Modified Davis grading
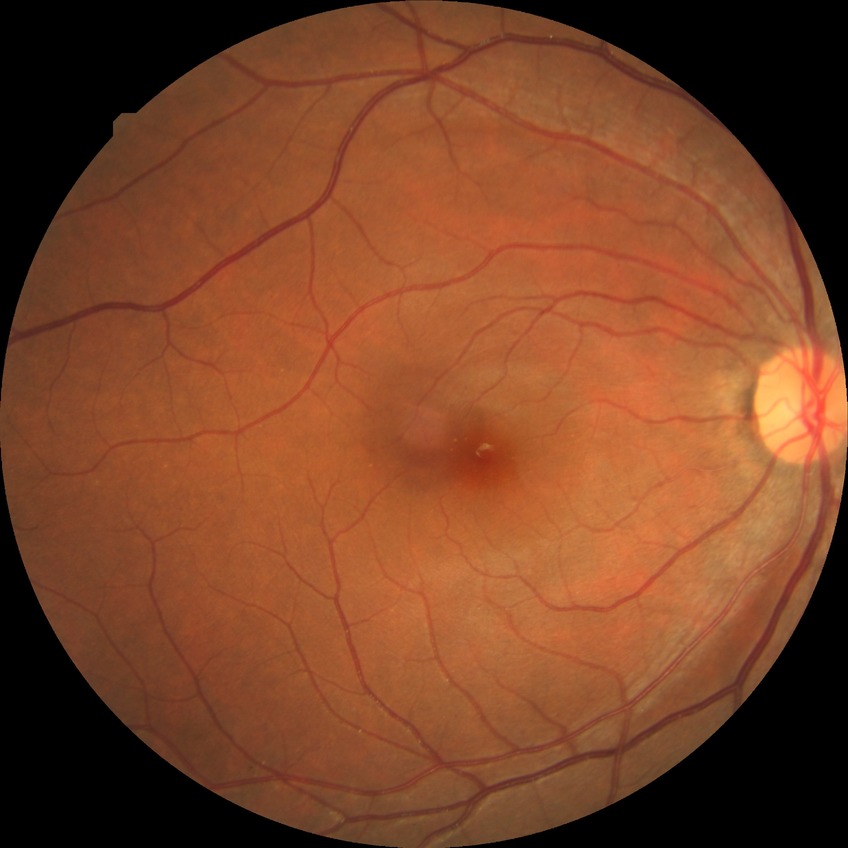 DR severity is NDR.
No apparent diabetic retinopathy.